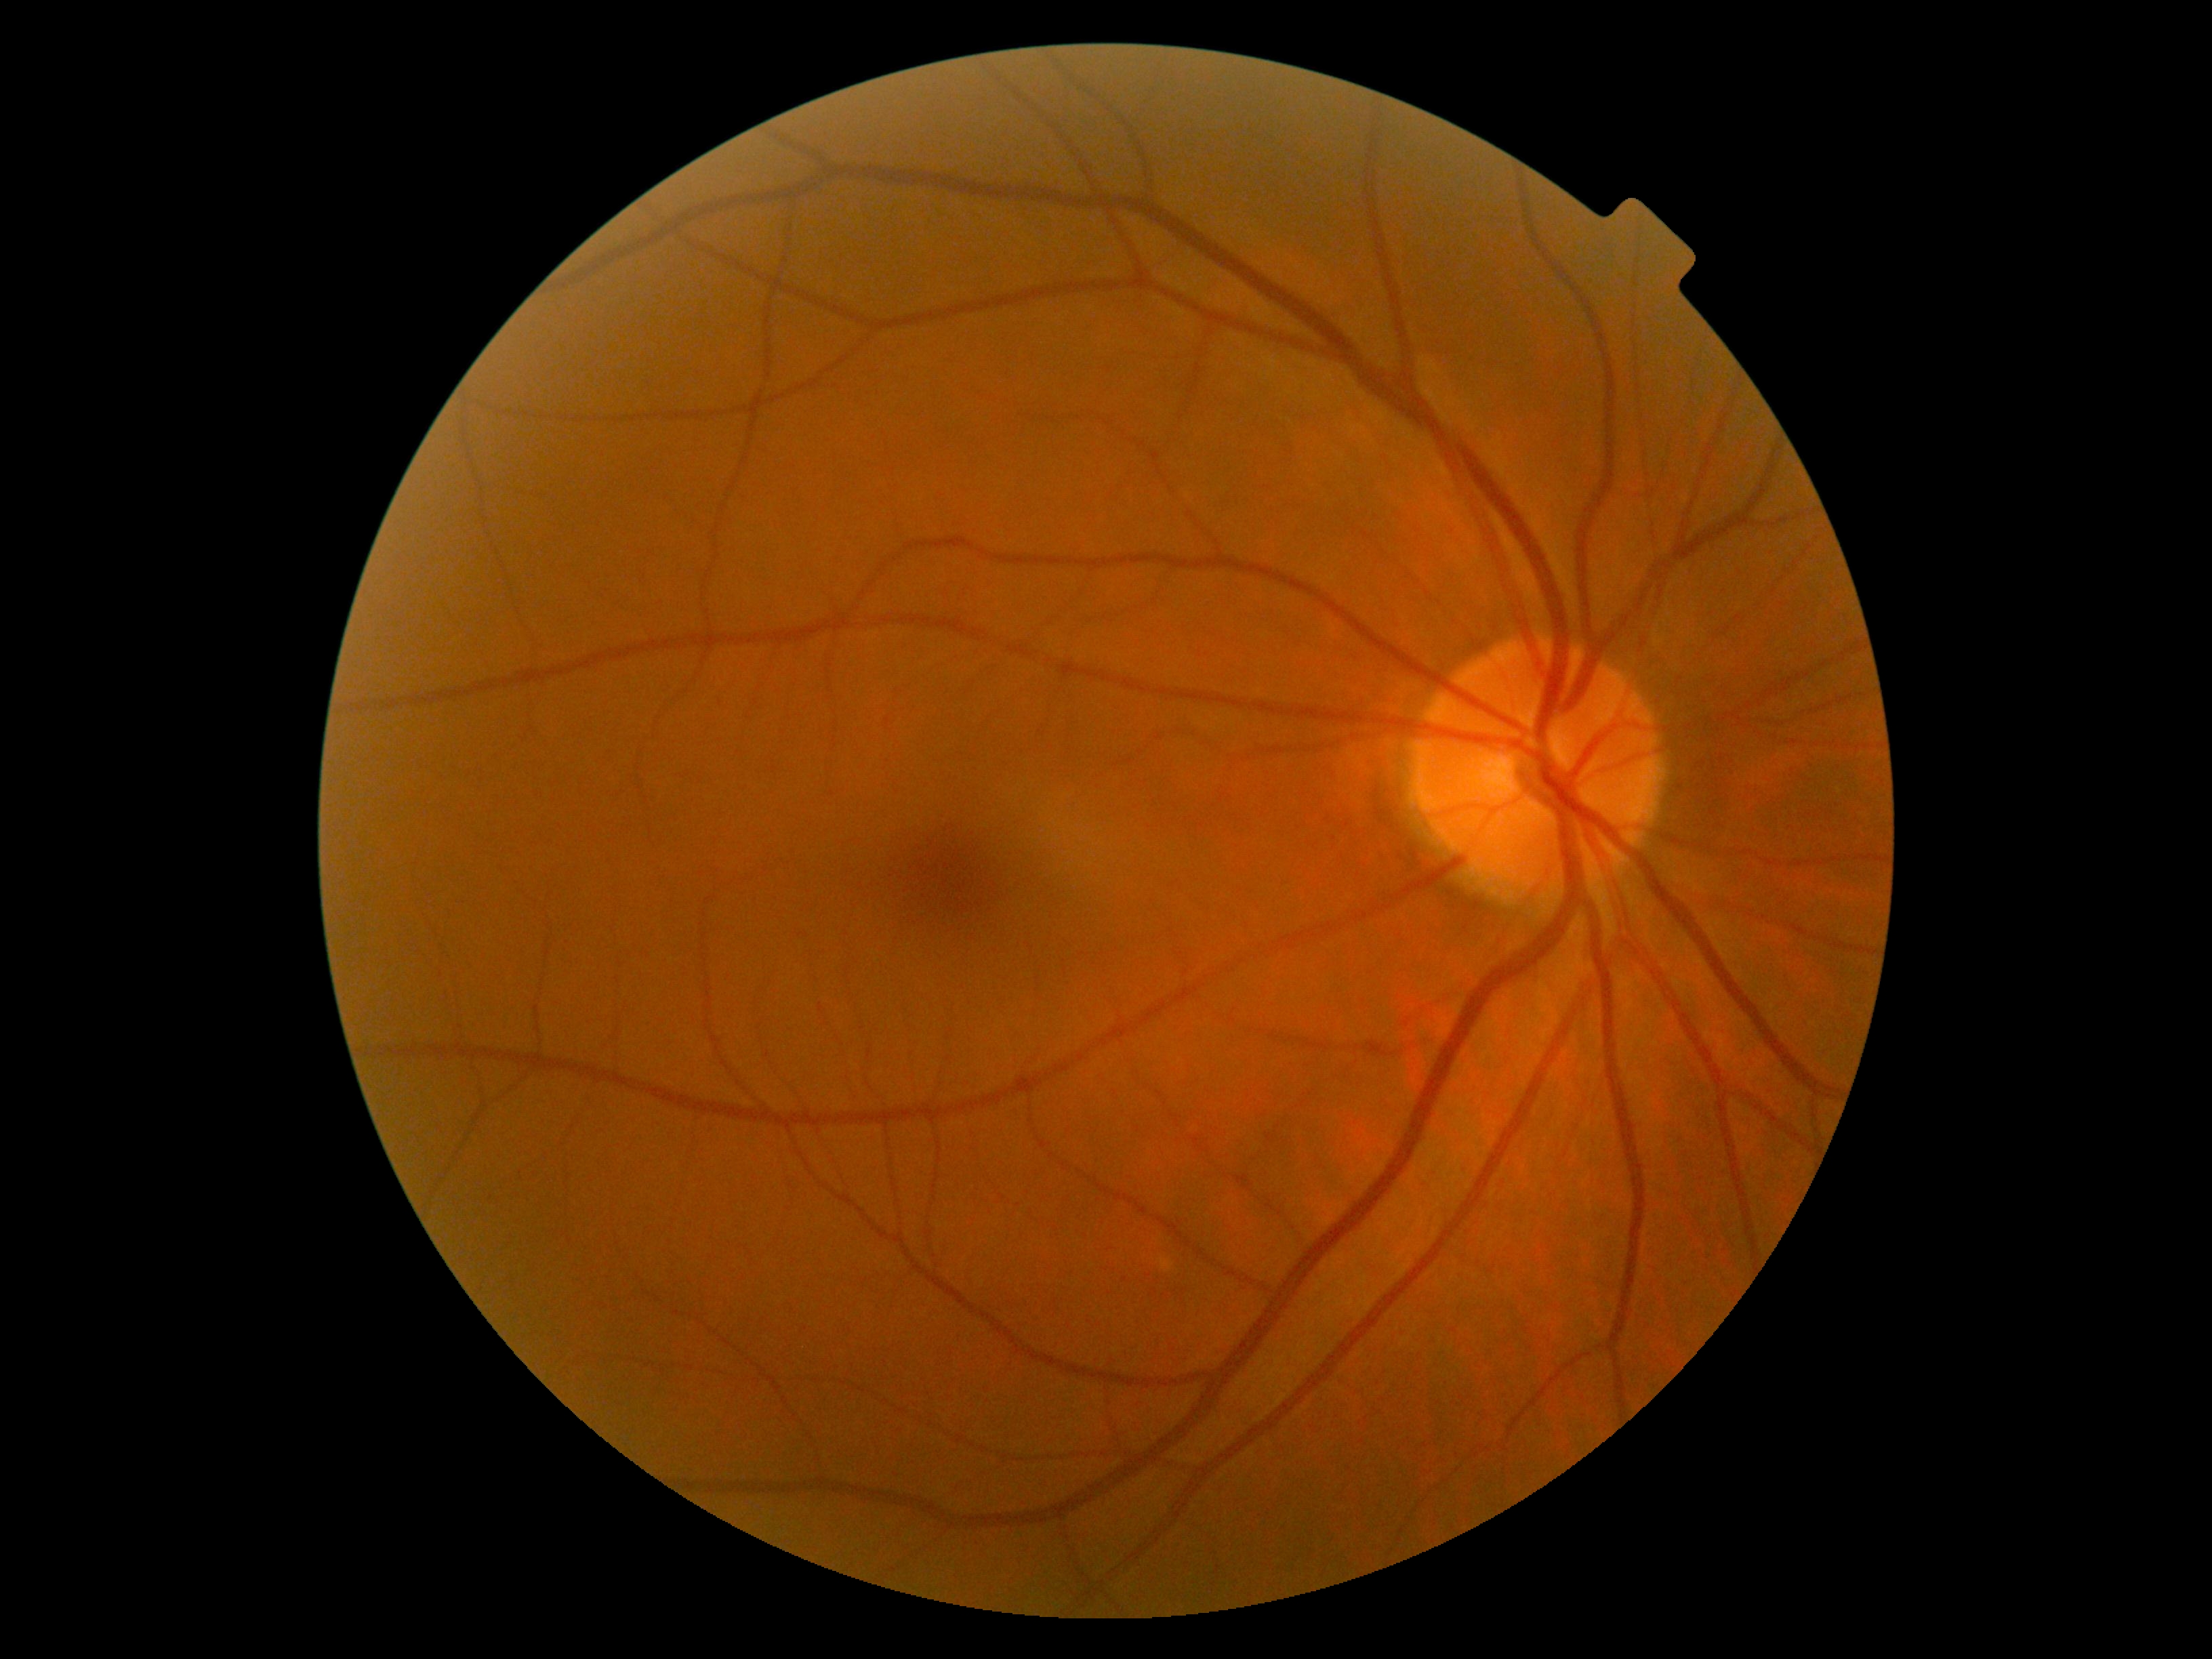 Diabetic retinopathy (DR): no apparent retinopathy (grade 0).